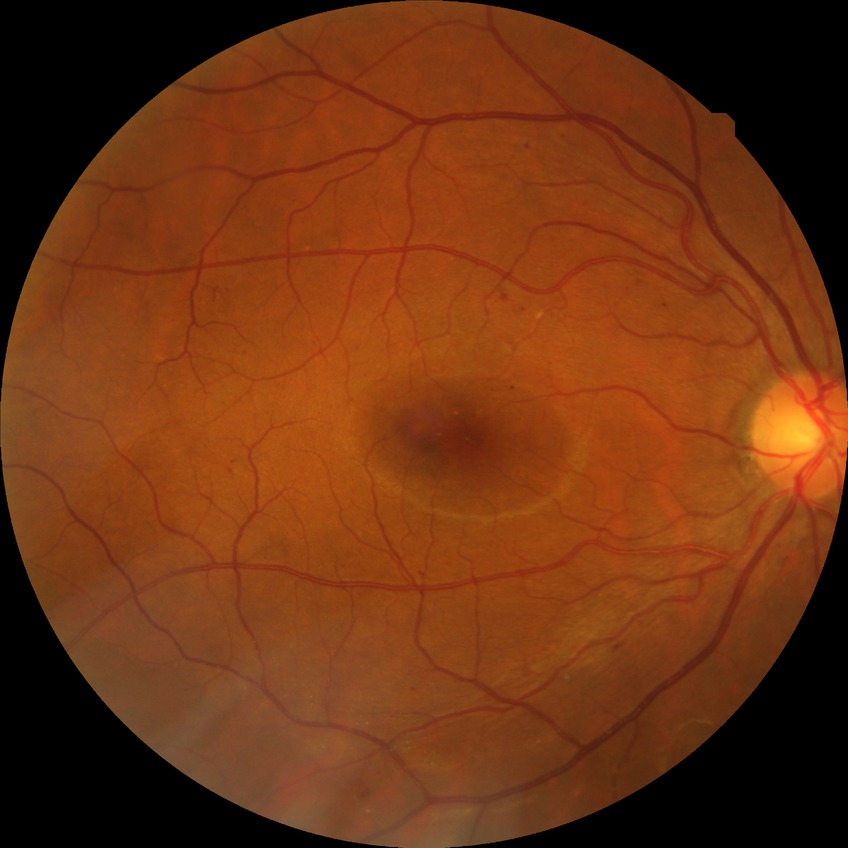

Disease class: non-proliferative diabetic retinopathy. Diabetic retinopathy (DR): SDR (simple diabetic retinopathy).